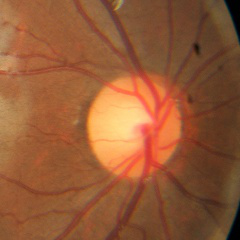 Findings consistent with no signs of glaucoma.